848x848; nonmydriatic.
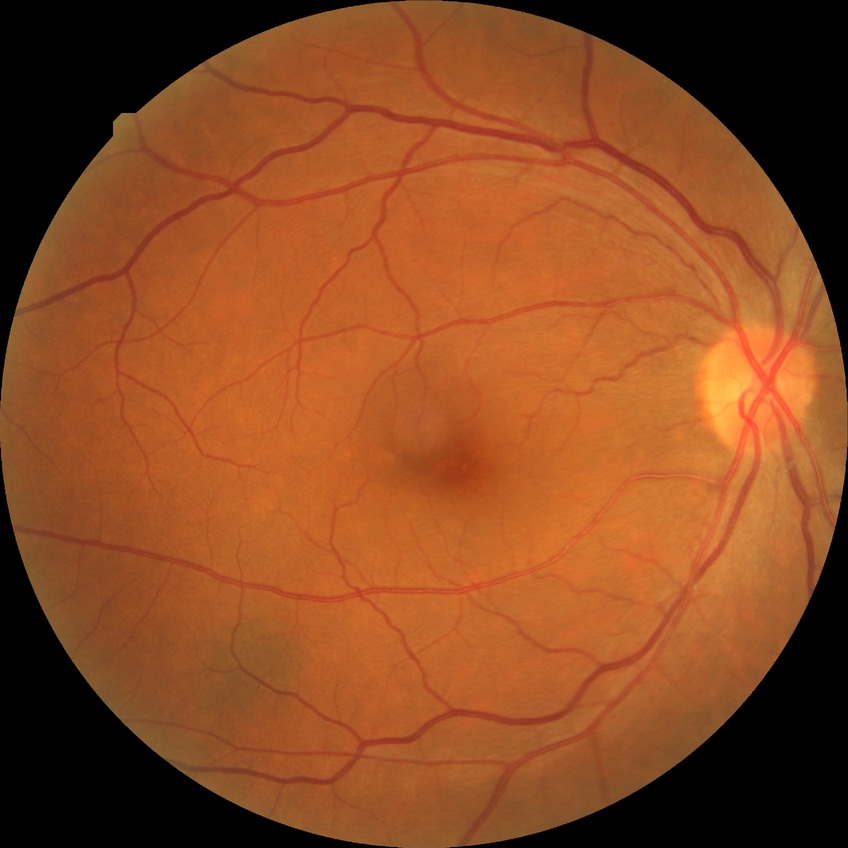 modified Davis classification: no diabetic retinopathy.